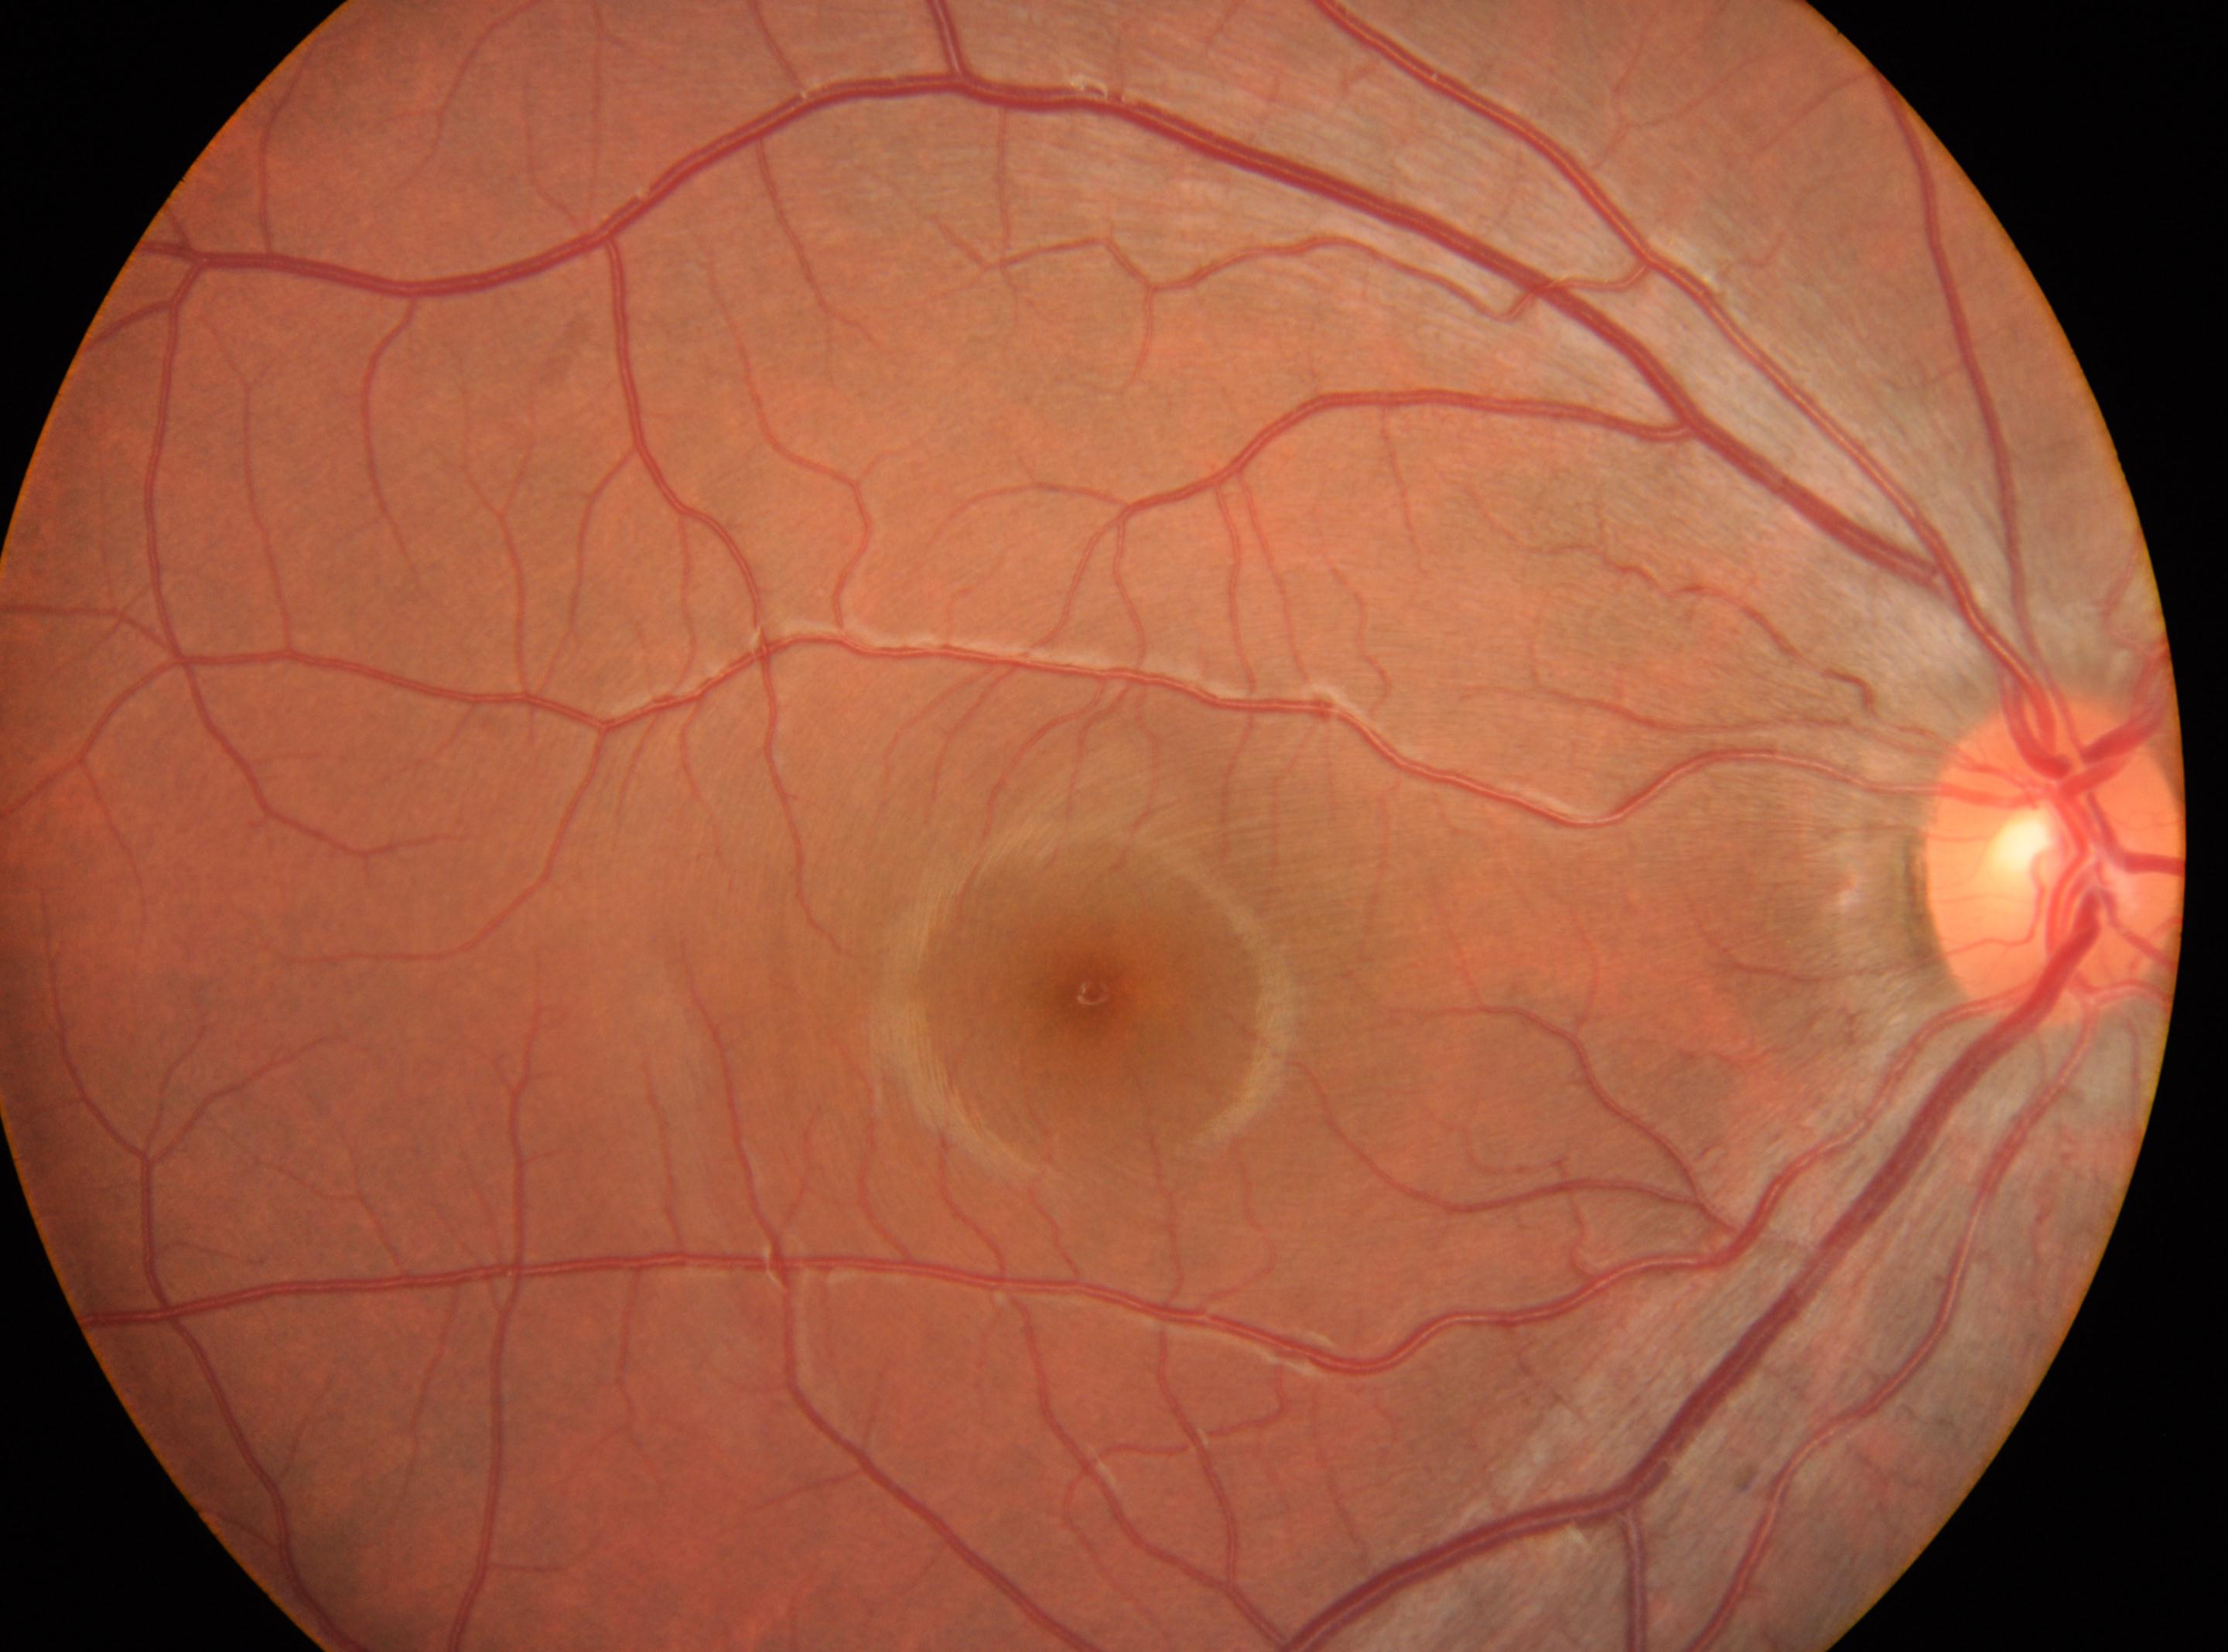
- macular center · 1092px, 998px
- DR grade · 0/4
- laterality · oculus dexter
- optic disc center · 2056px, 860px